45° field of view — 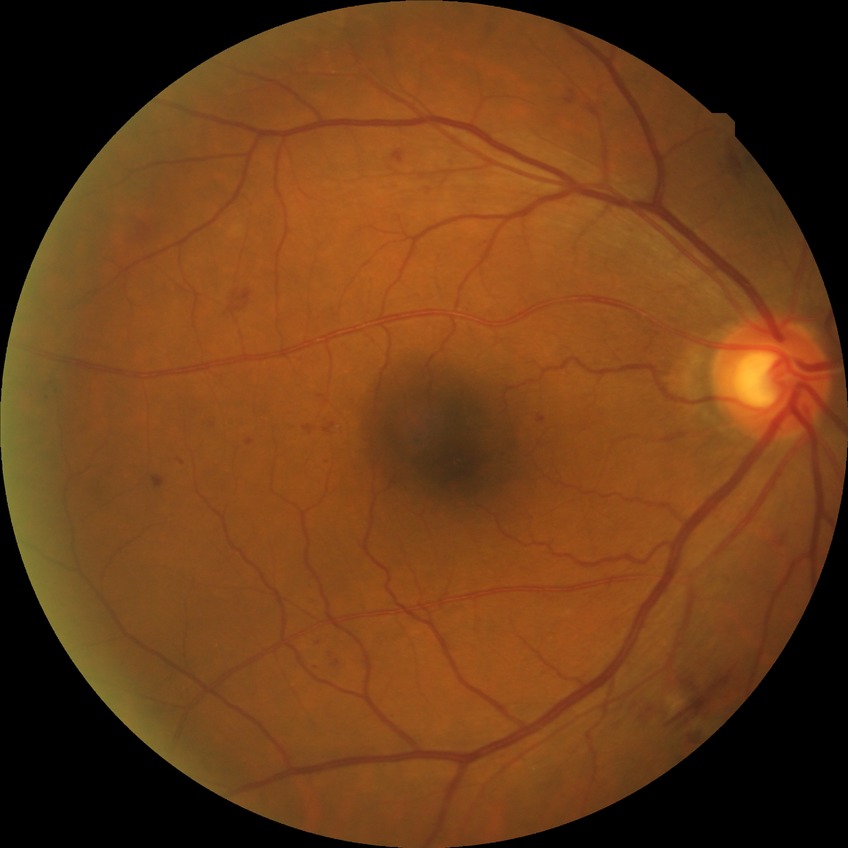
Diabetic retinopathy (DR) is simple diabetic retinopathy (SDR).